Retinal fundus photograph — 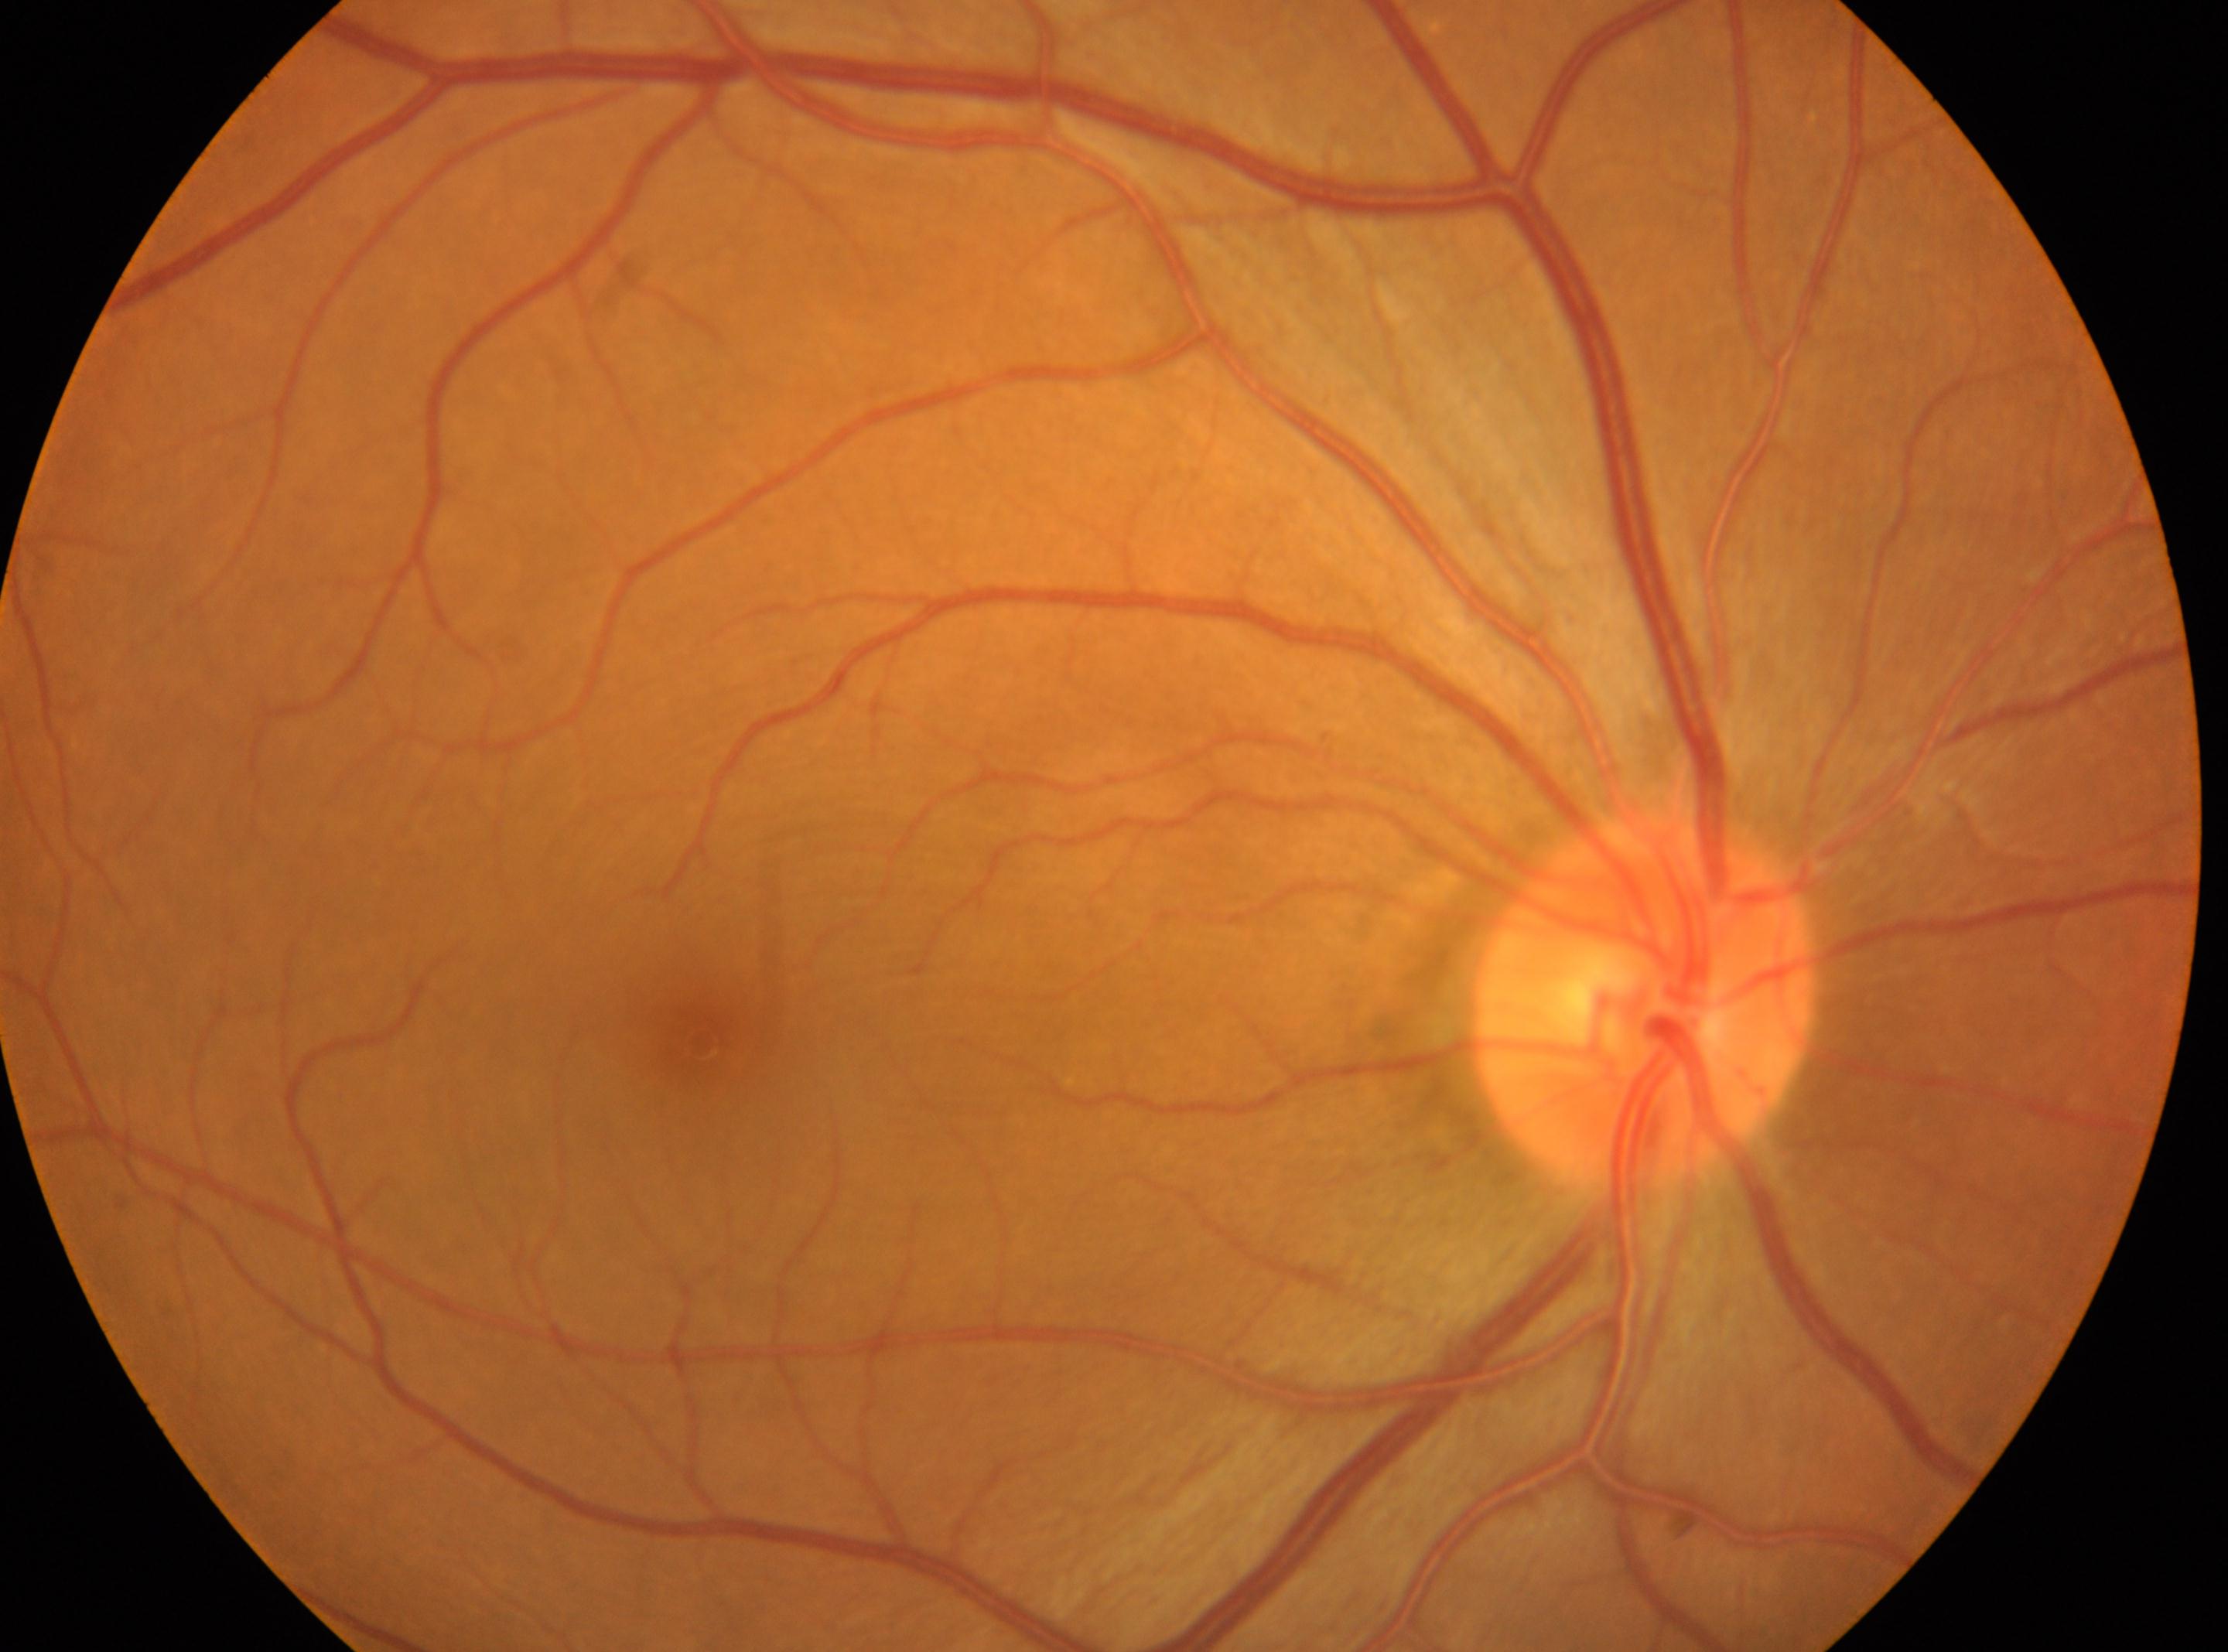

Q: Is there DR?
A: No DR findings
Q: Diabetic retinopathy severity?
A: 0 — no visible signs of diabetic retinopathy
Q: Right or left eye?
A: oculus dexter
Q: Locate the fovea.
A: (699, 1043)
Q: Optic disc center?
A: (1643, 1001)